Camera: NIDEK AFC-230. 45° field of view. 848 by 848 pixels. Posterior pole color fundus photograph: 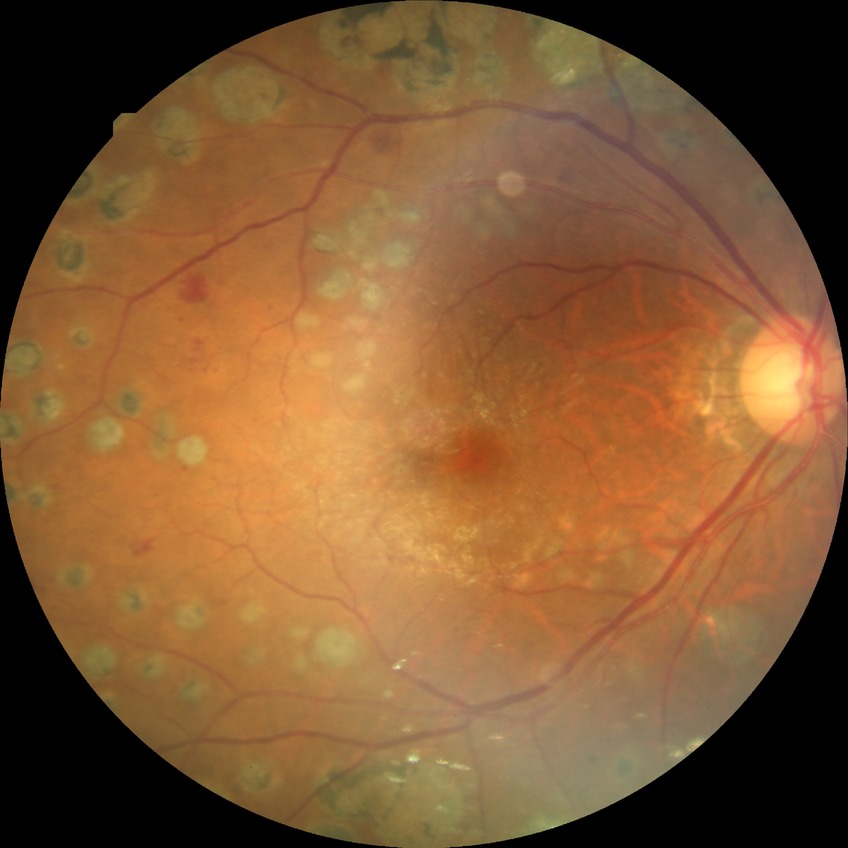

davis_grade: proliferative diabetic retinopathy (PDR)